Infant wide-field fundus photograph: 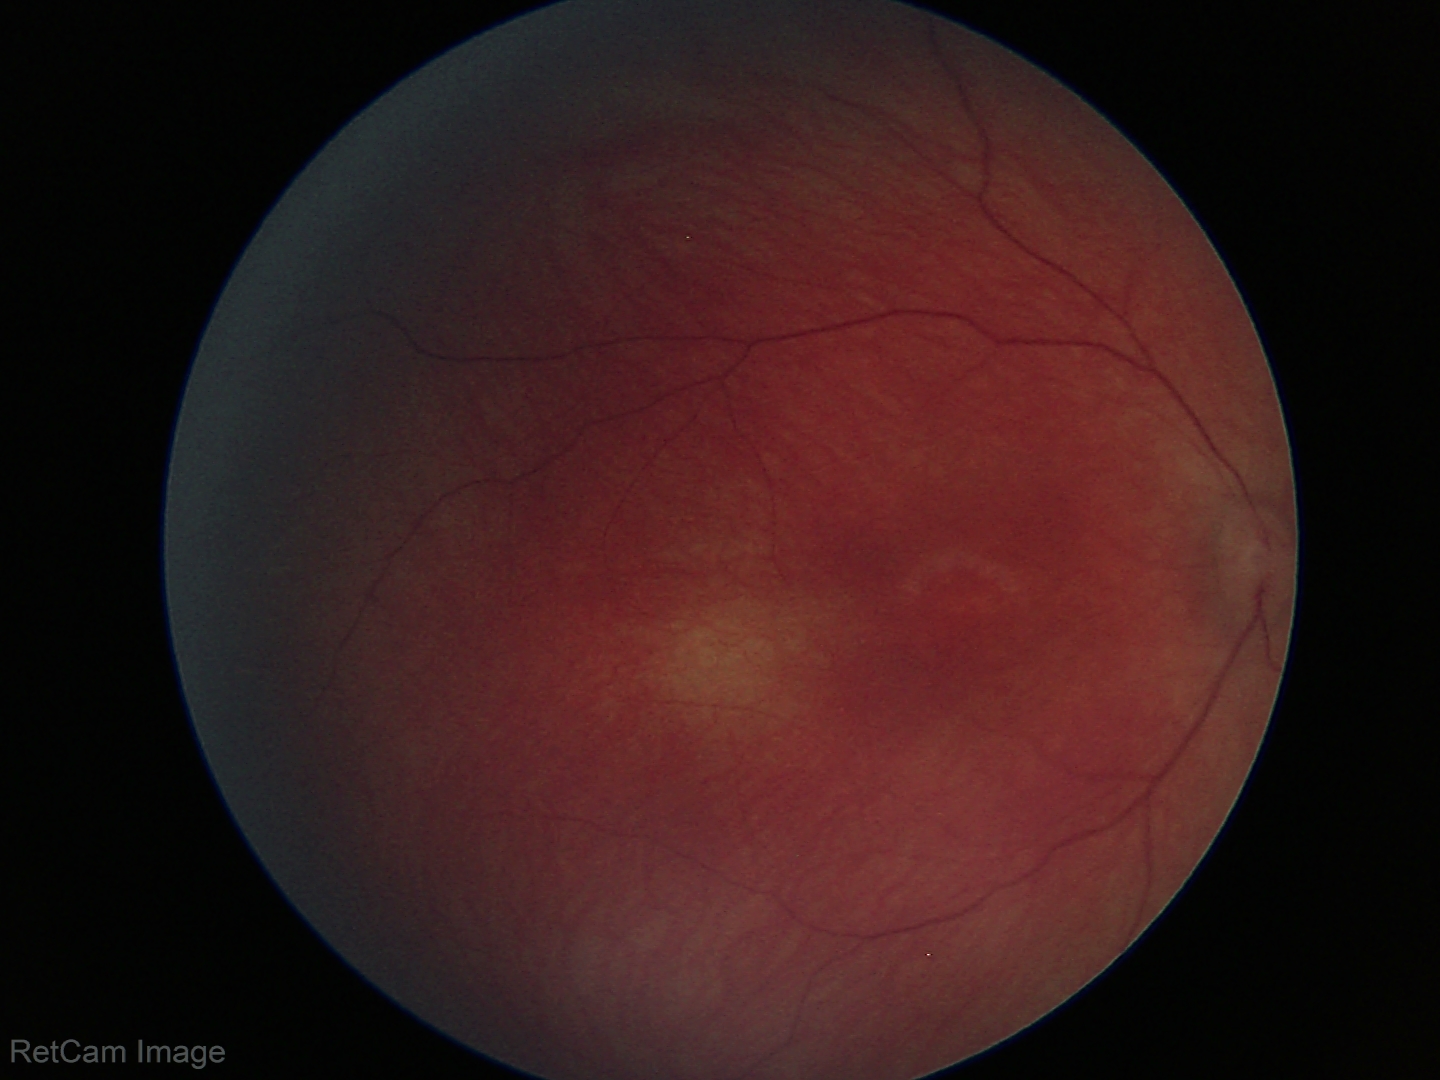

Normal screening examination.